1240 x 1240 pixels; Phoenix ICON, 100° FOV; infant wide-field fundus photograph — 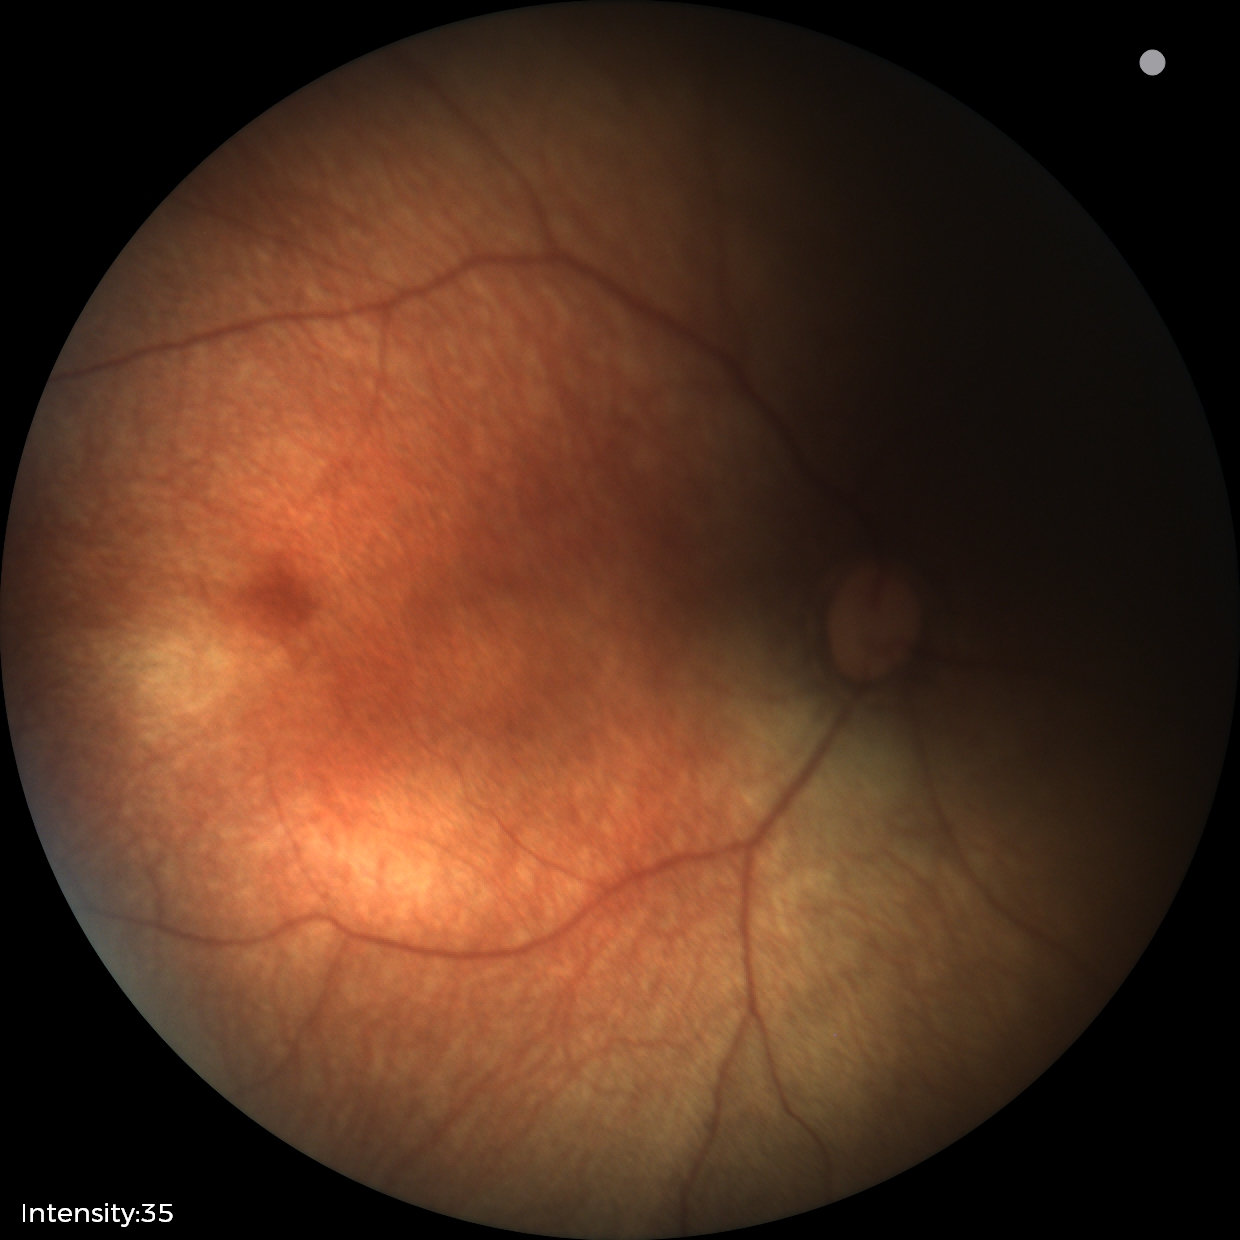
Assessment: physiological appearance with no retinal pathology.